Optic disc region crop
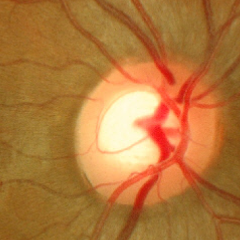

No glaucoma.